Color fundus image; 2048x1536px — 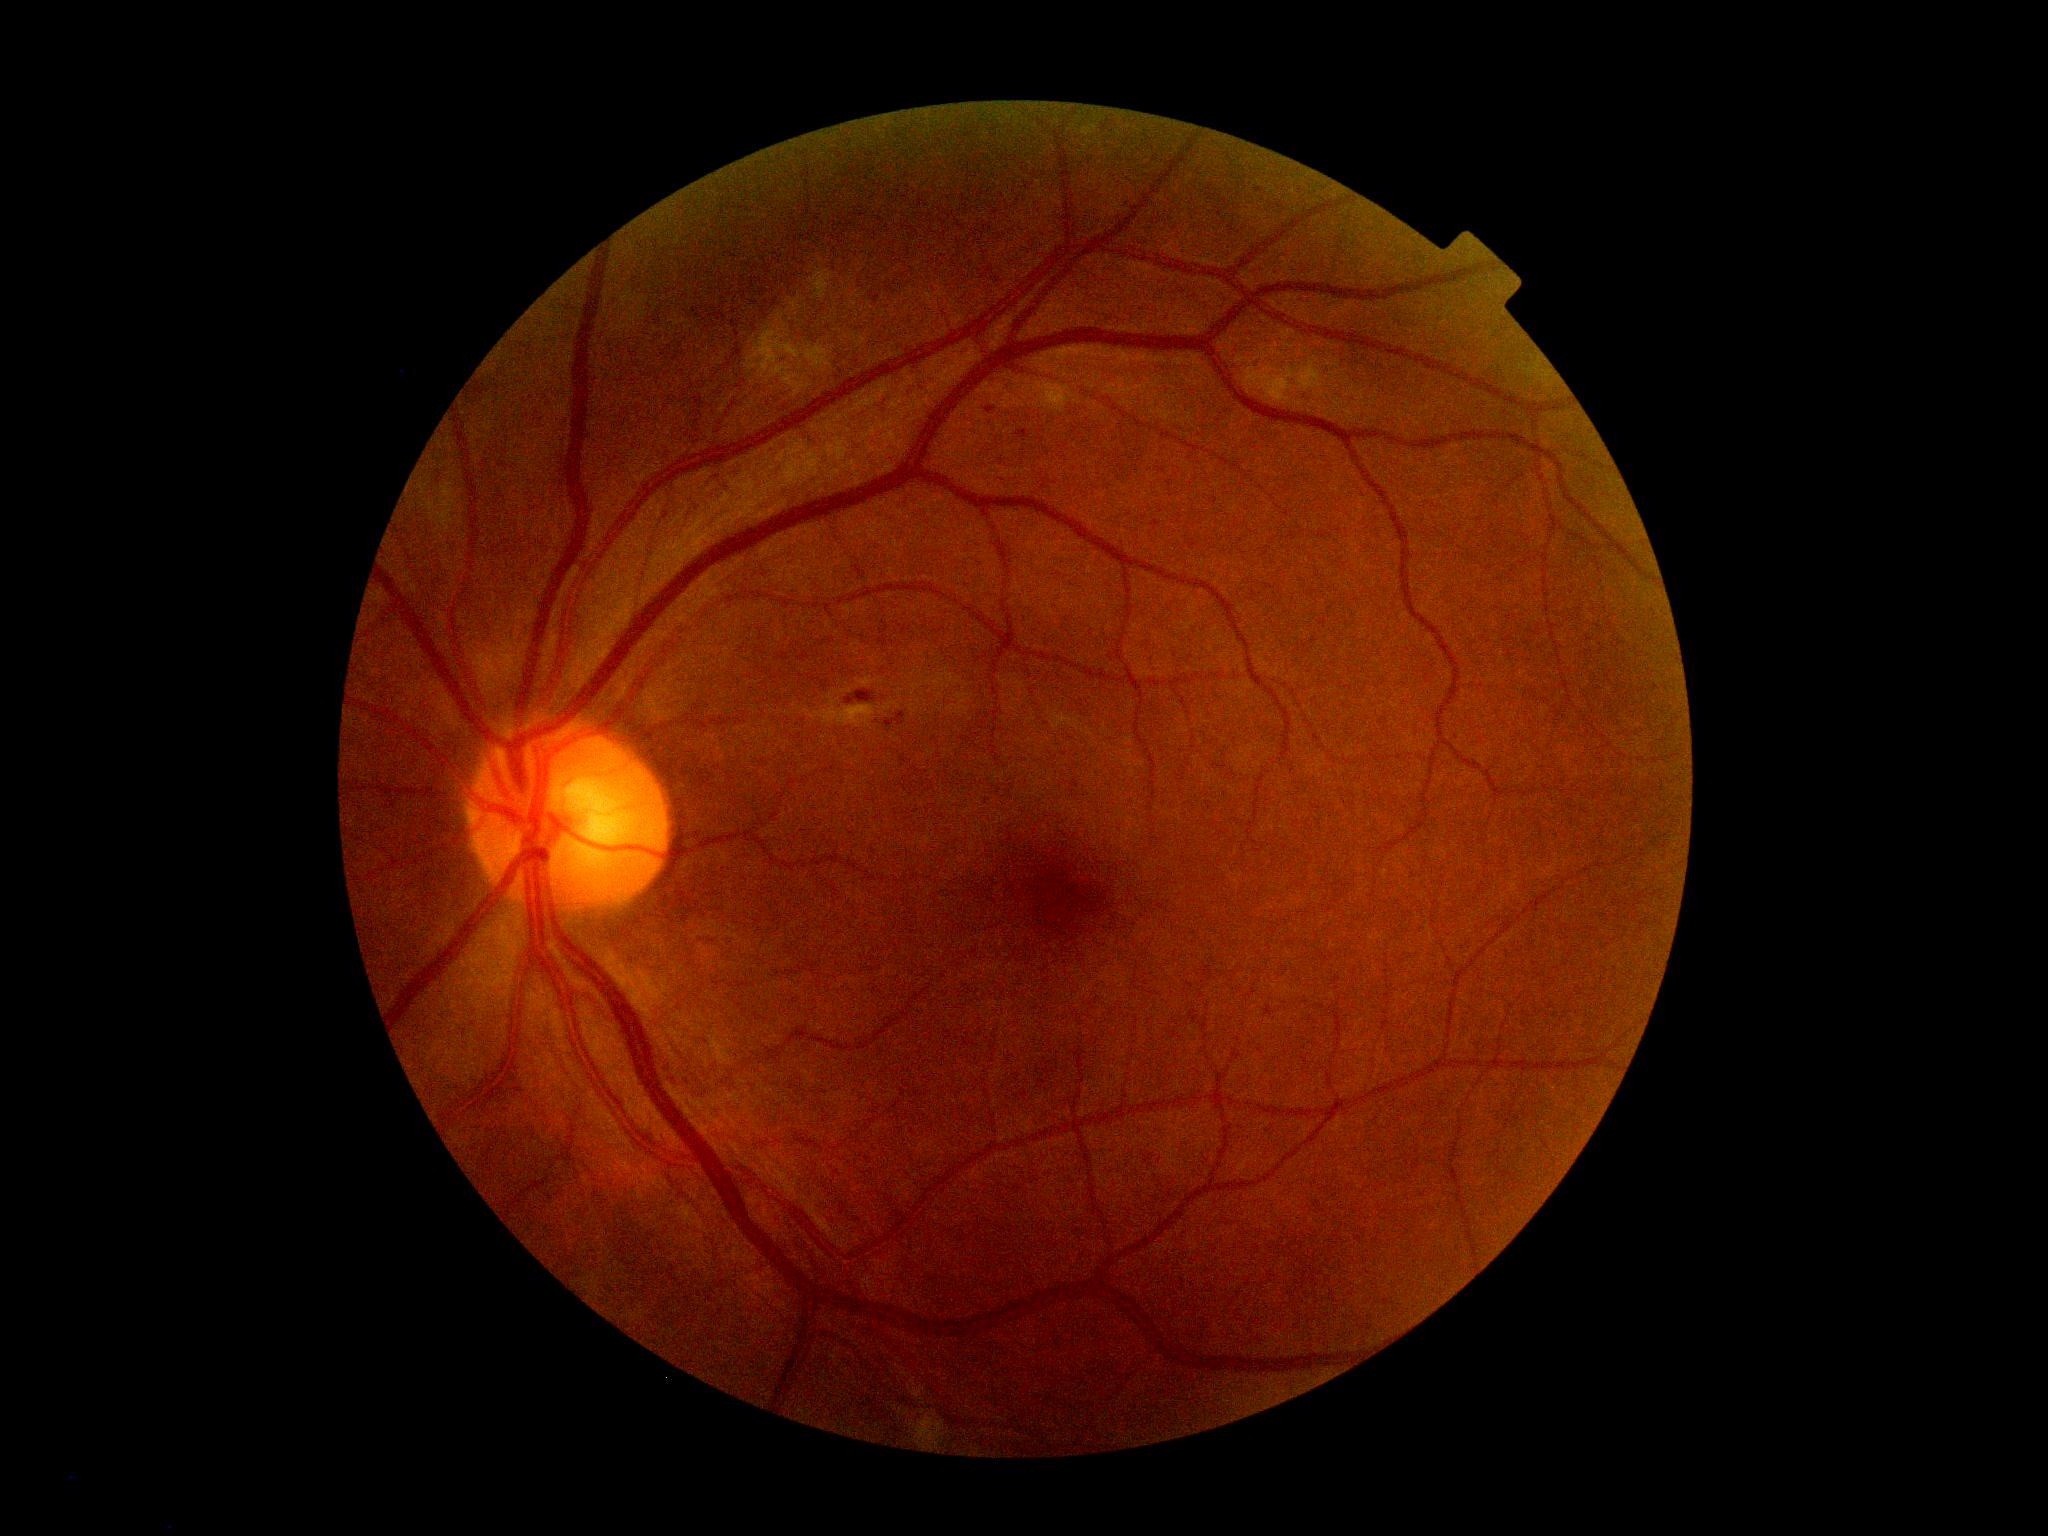 Diabetic retinopathy (DR): 2/4.